Wide-field fundus image from infant ROP screening
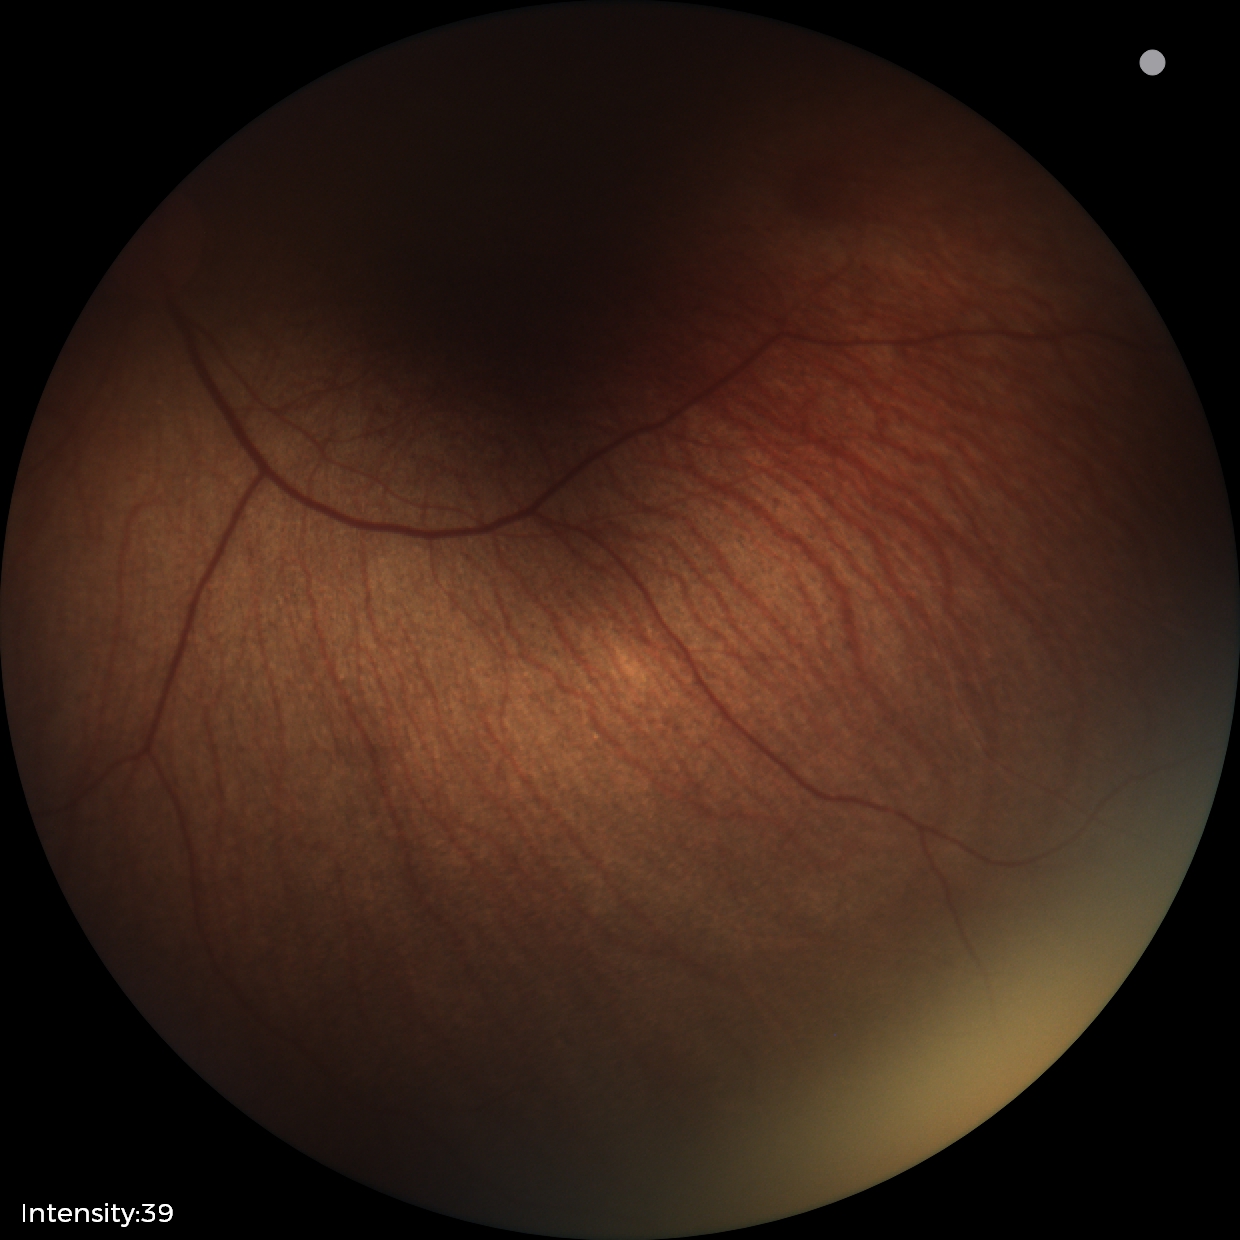

Q: What is the diagnosis from this examination?
A: no abnormal retinal findings